Dilated-pupil acquisition; macula-centered field:
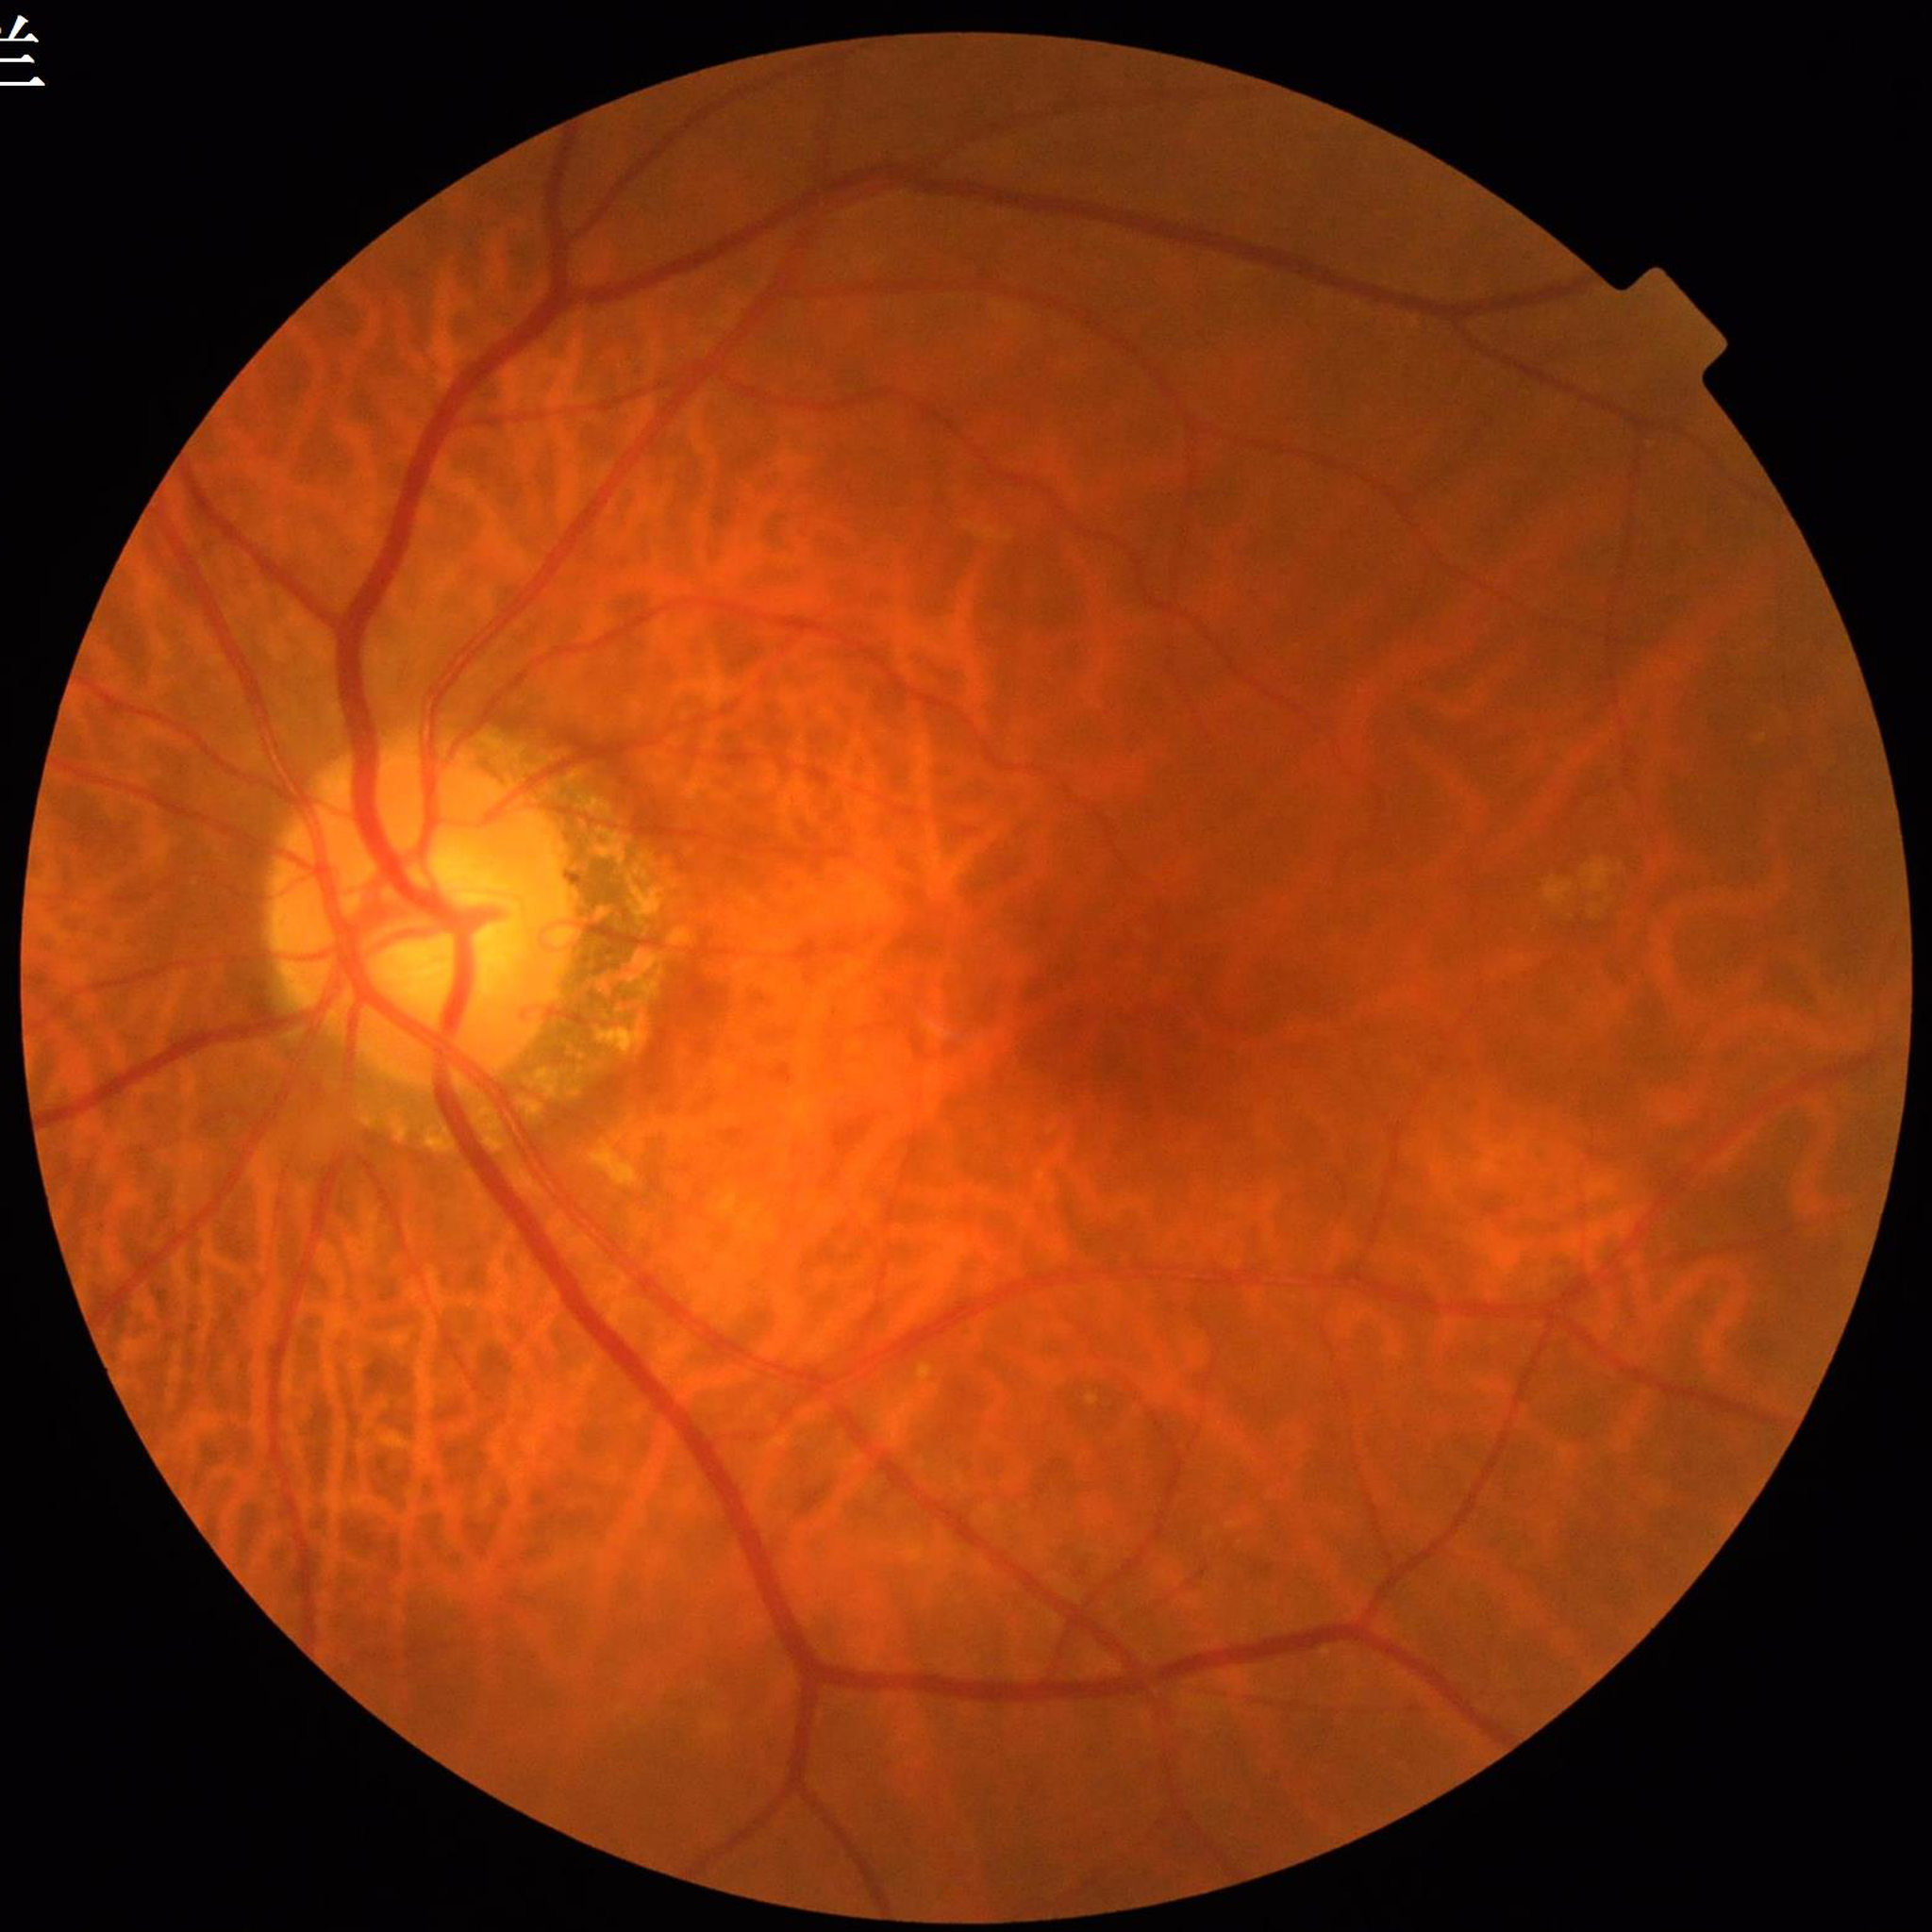
From a patient with diabetic retinopathy.